CFP
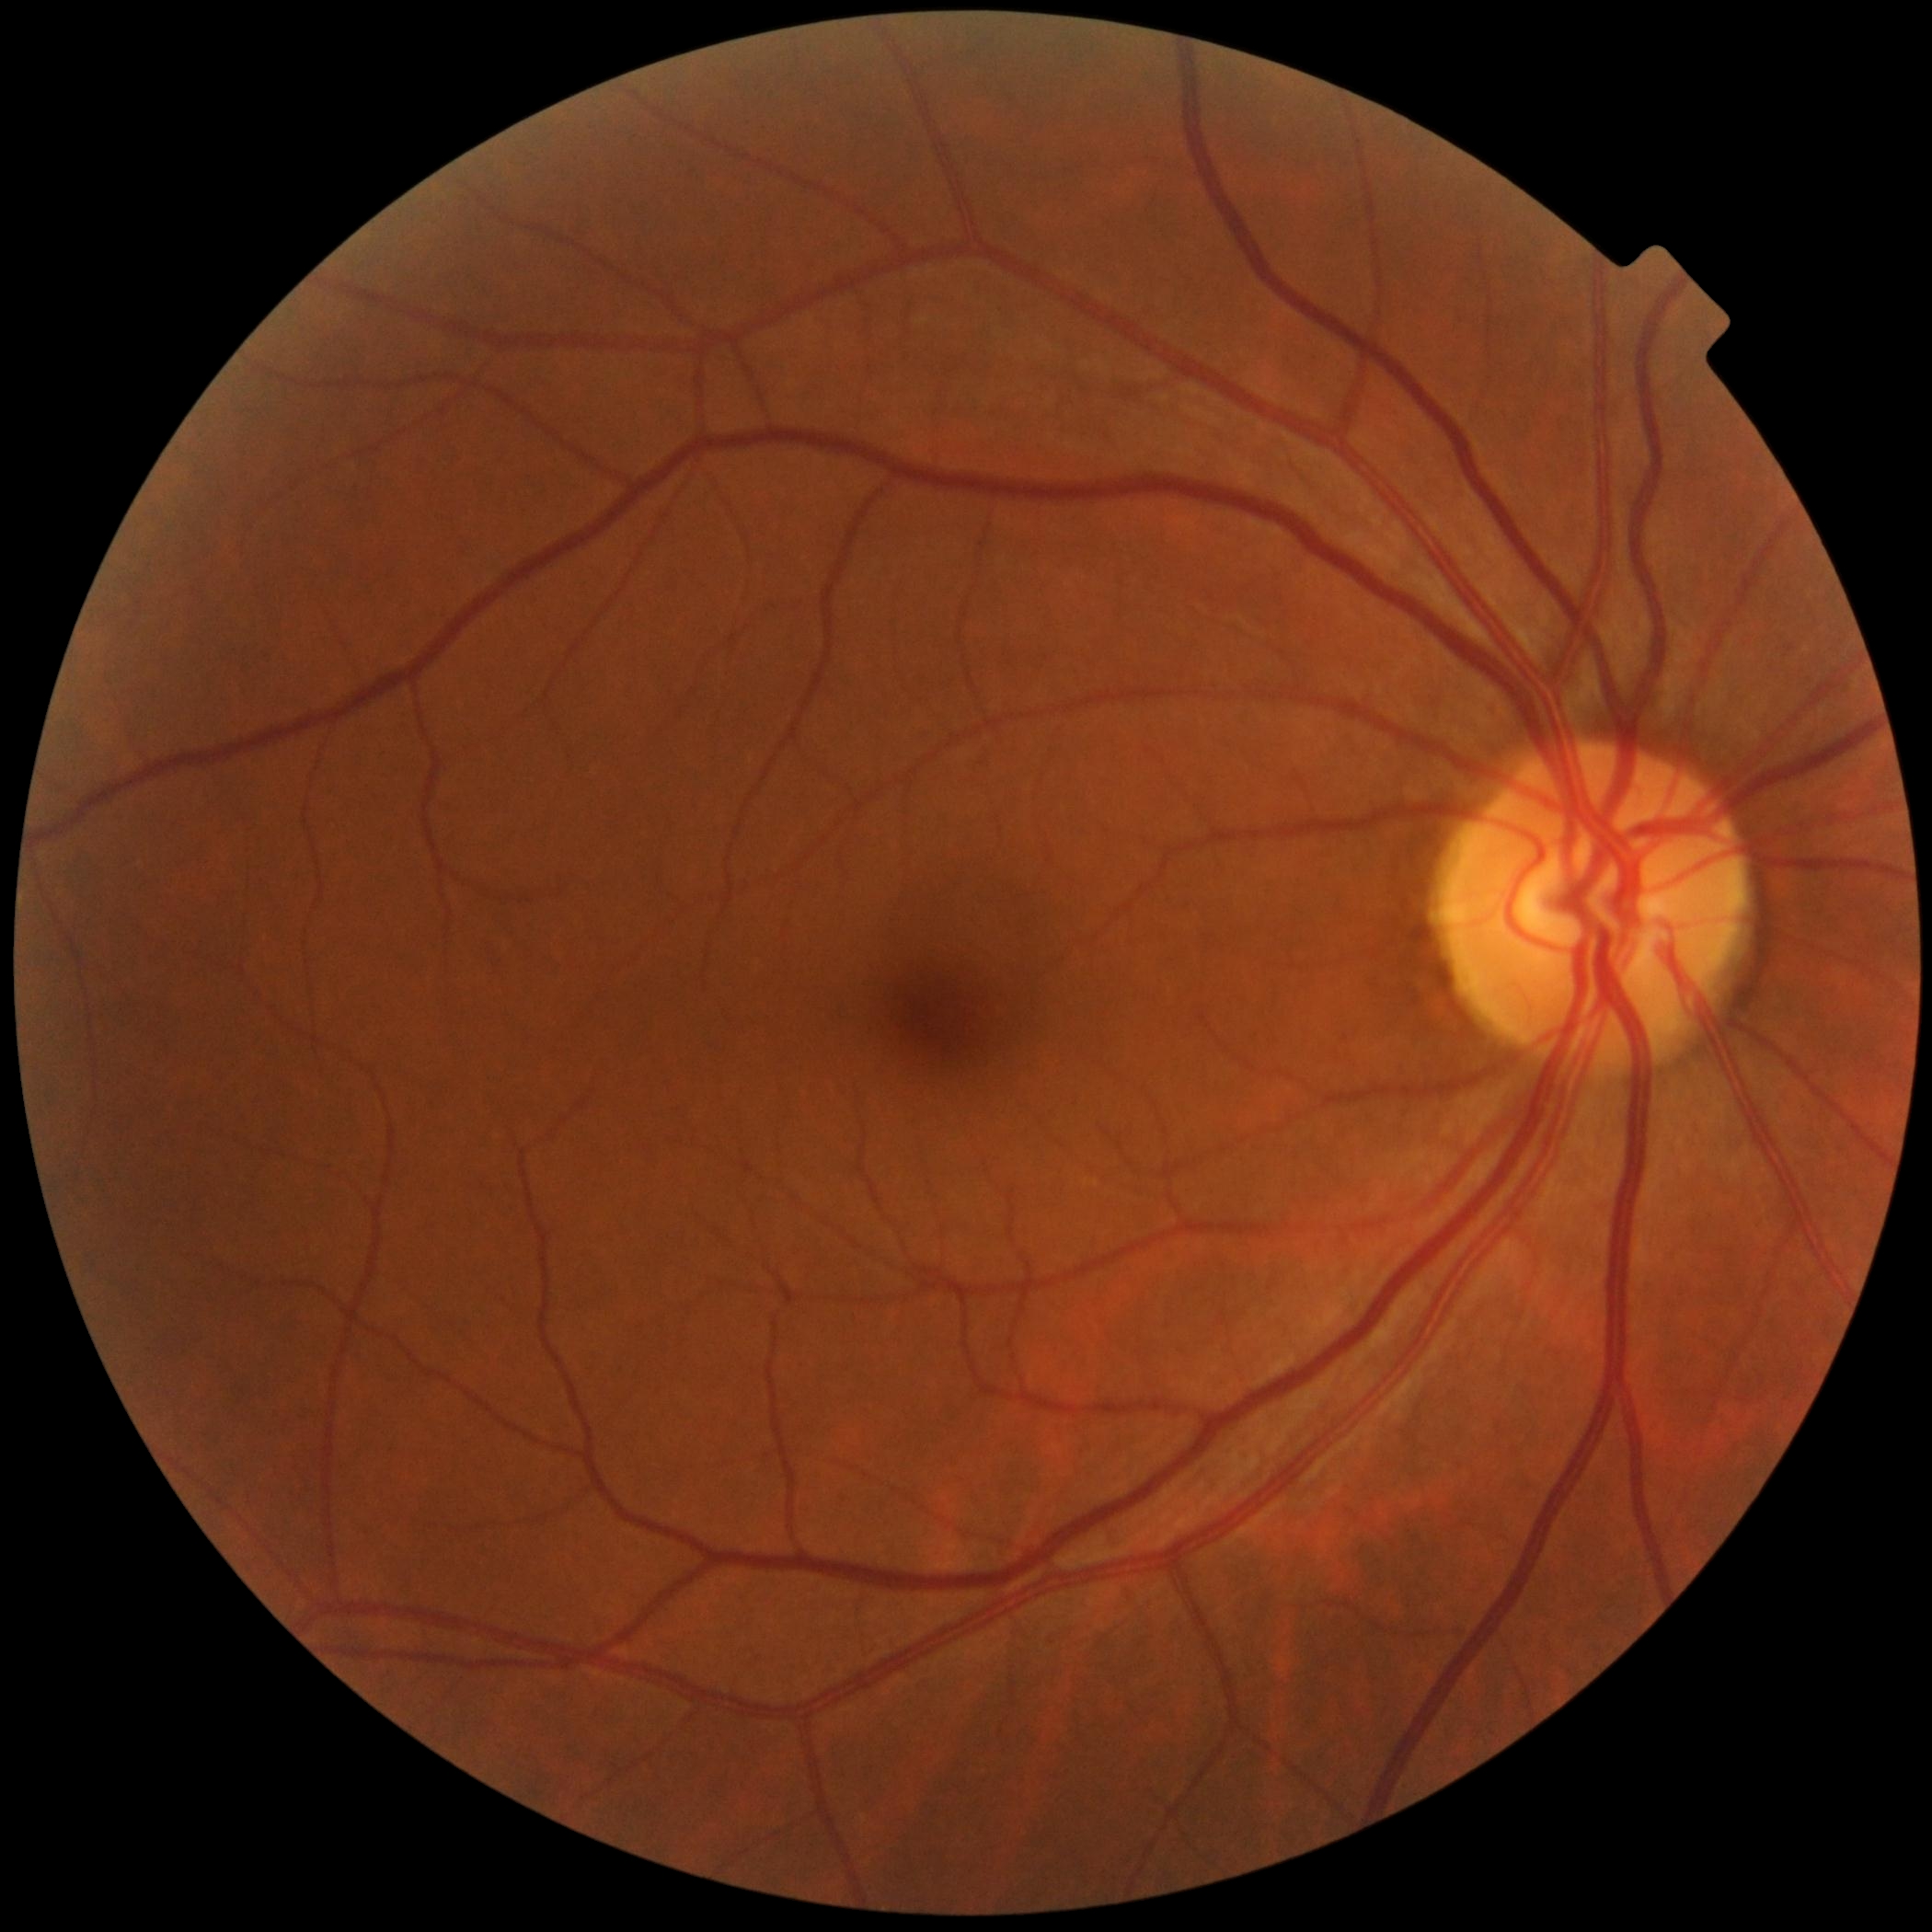

Diabetic retinopathy severity: grade 0.
No DR findings.